Diabetic retinopathy graded by the modified Davis classification. Acquired with a NIDEK AFC-230. Nonmydriatic. 848 by 848 pixels:
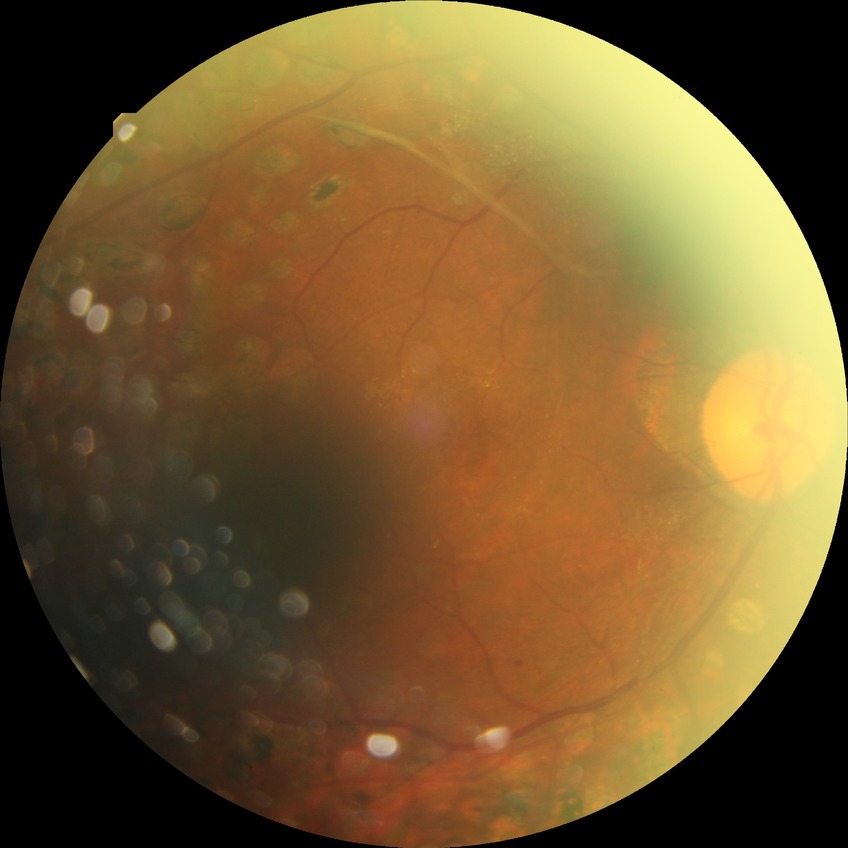 Diabetic retinopathy grade: proliferative diabetic retinopathy.